Color fundus image. 45° field of view
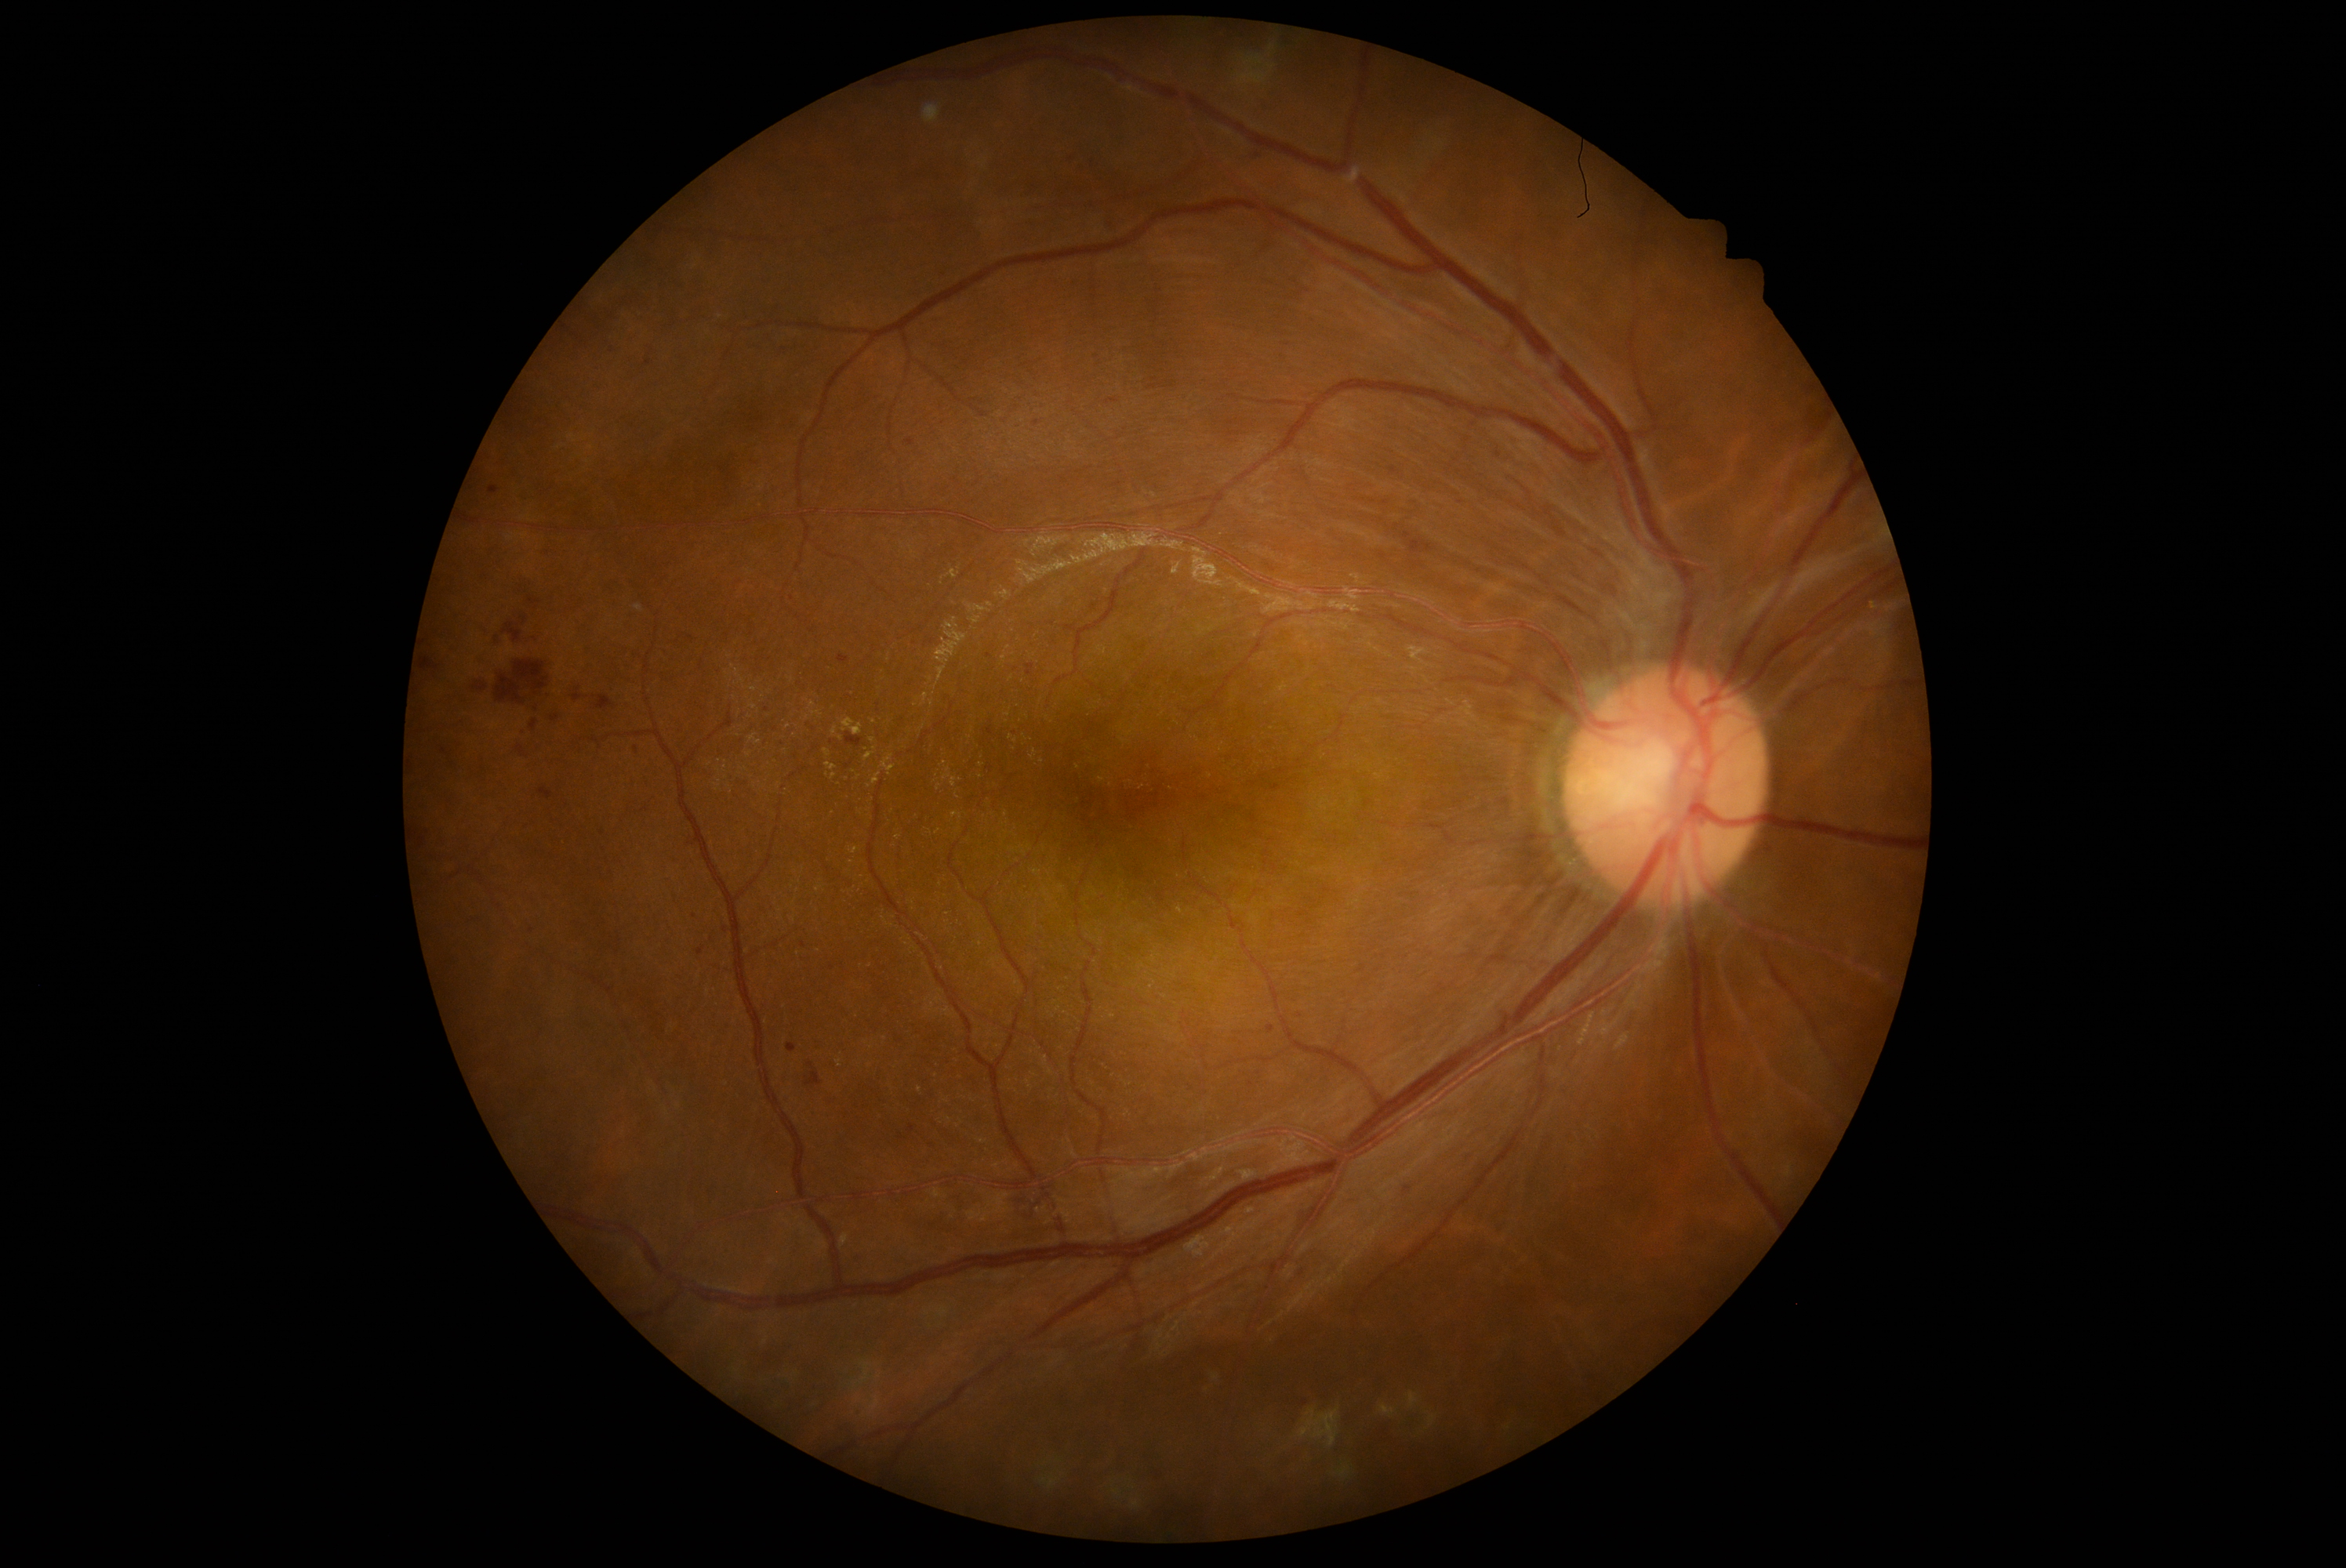

<lesions partial="true">
  <dr_grade>2</dr_grade>
  <se />
  <he partial="true"><region>1255, 153, 1263, 159</region>, <region>786, 1044, 797, 1053</region>, <region>424, 658, 440, 670</region>, <region>528, 597, 542, 606</region>, <region>697, 948, 705, 957</region>, <region>495, 661, 550, 705</region>, <region>488, 487, 499, 495</region>, <region>503, 623, 521, 642</region>, <region>1026, 666, 1034, 677</region>, <region>539, 788, 553, 799</region>, <region>909, 1125, 915, 1134</region>, <region>898, 1133, 906, 1141</region>, <region>573, 695, 581, 702</region>, <region>846, 733, 863, 747</region>, <region>1404, 1186, 1412, 1194</region></he>
  <he_small>x=695 y=917, x=537 y=709</he_small>
  <ex partial="true"><region>943, 775, 957, 788</region>, <region>843, 719, 863, 735</region>, <region>824, 750, 832, 757</region>, <region>849, 848, 860, 855</region>, <region>826, 764, 837, 771</region></ex>
  <ex_small>x=834 y=777, x=859 y=777, x=874 y=748, x=869 y=787, x=852 y=861, x=948 y=770, x=828 y=775</ex_small>
  <ma />
</lesions>